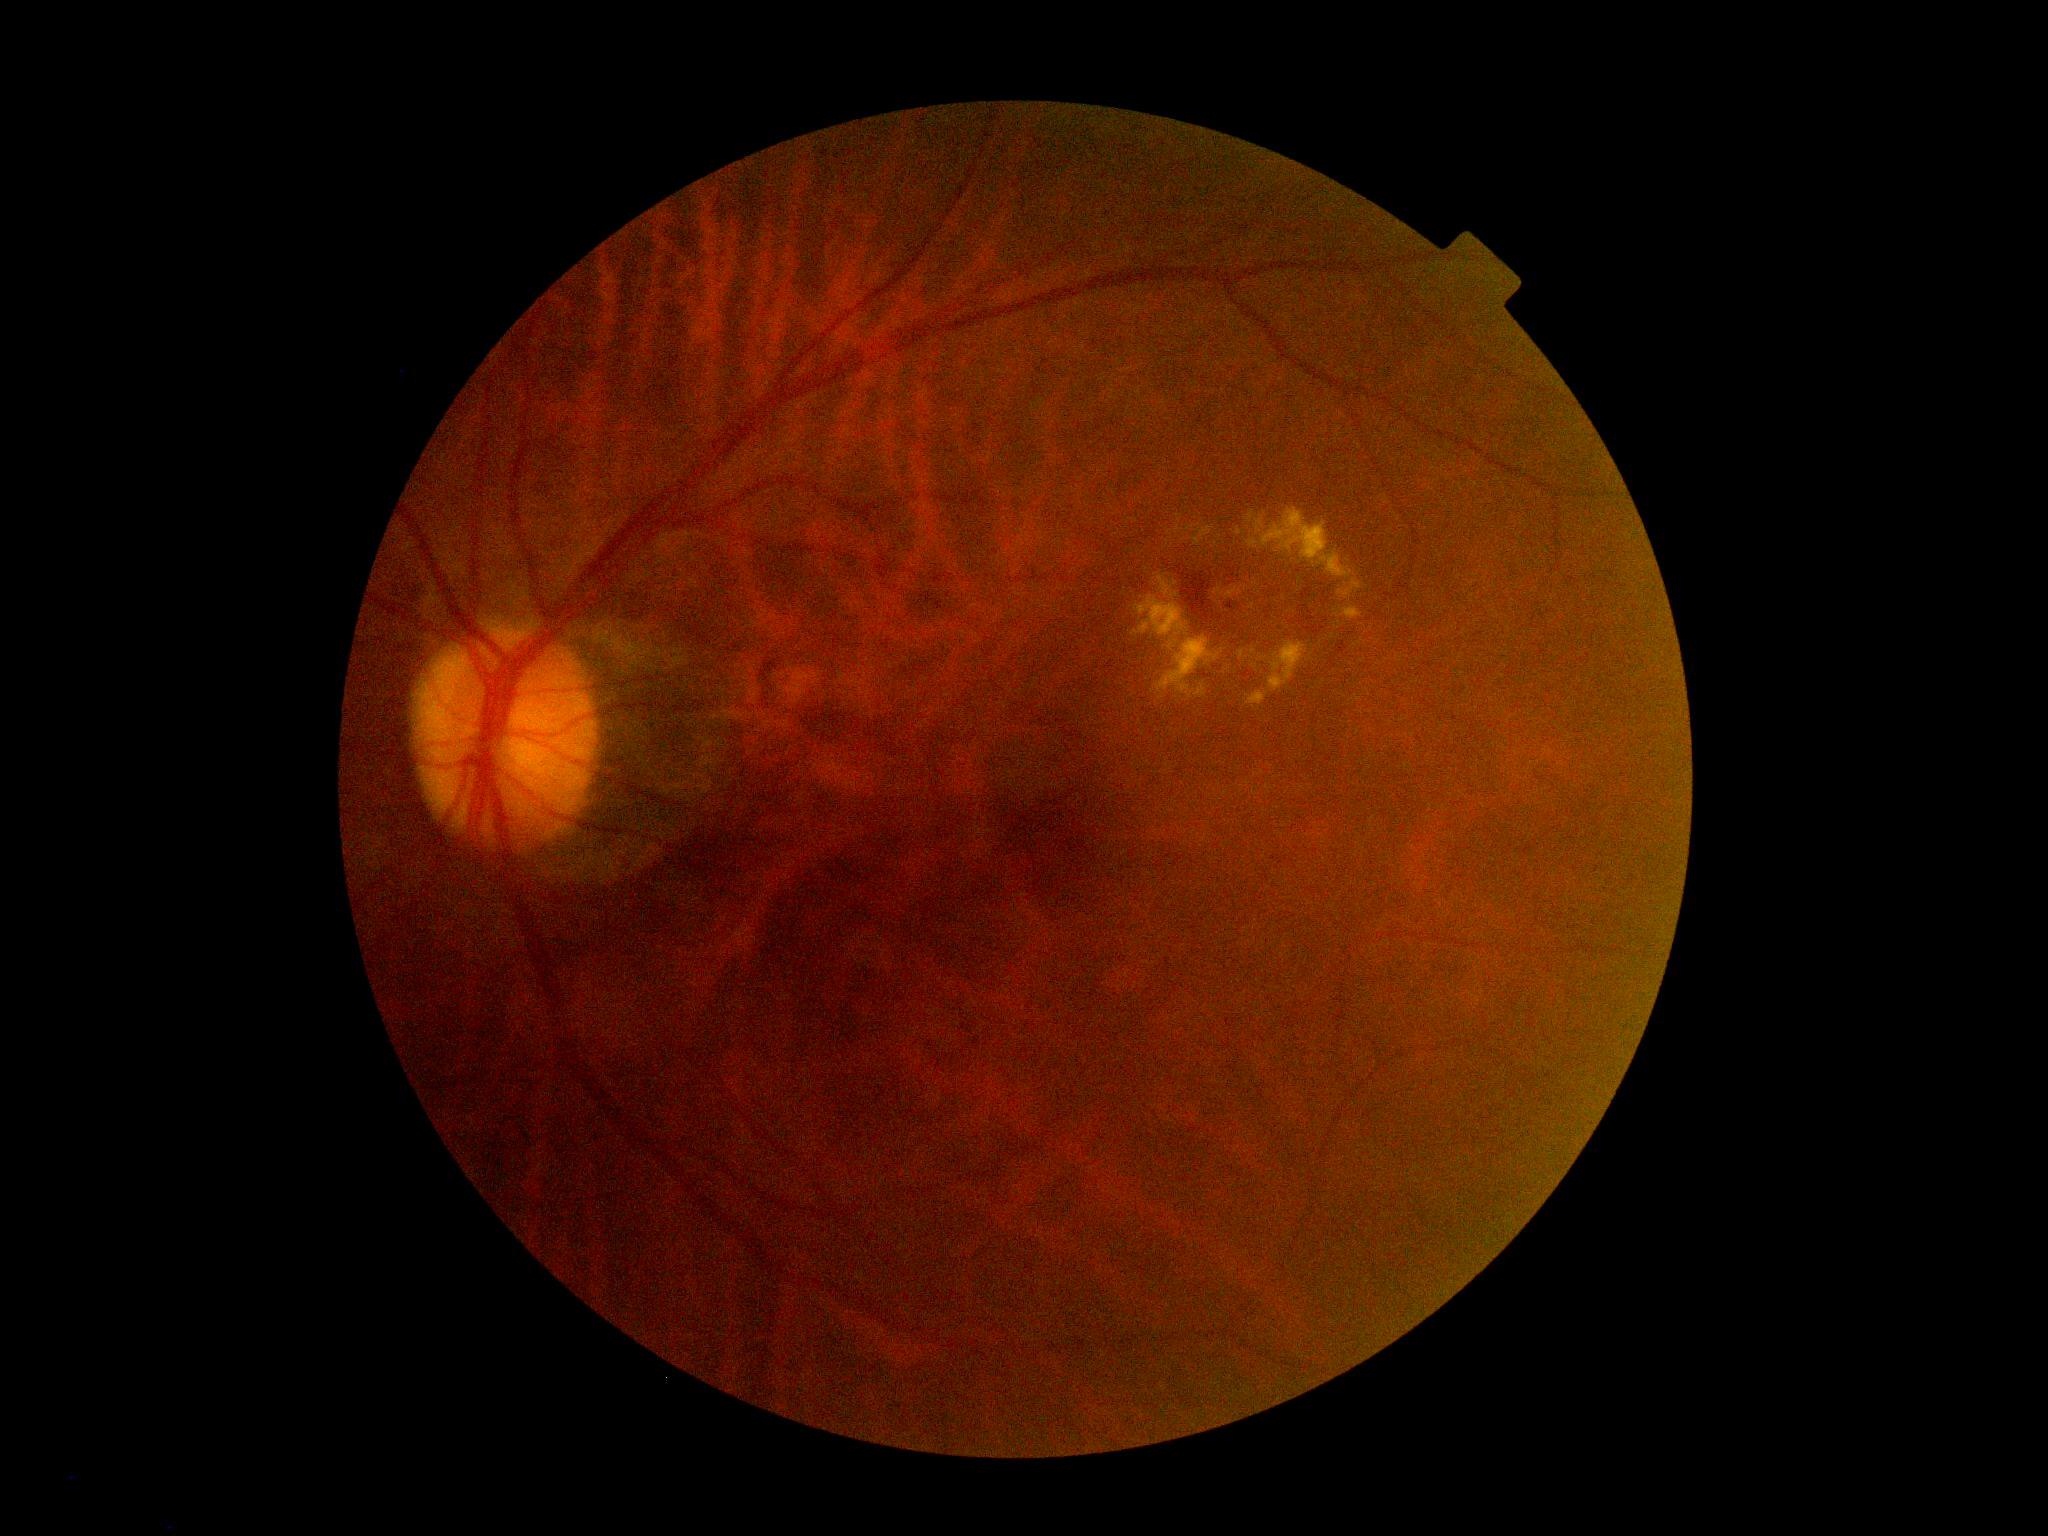 {
  "dr_grade": "2"
}